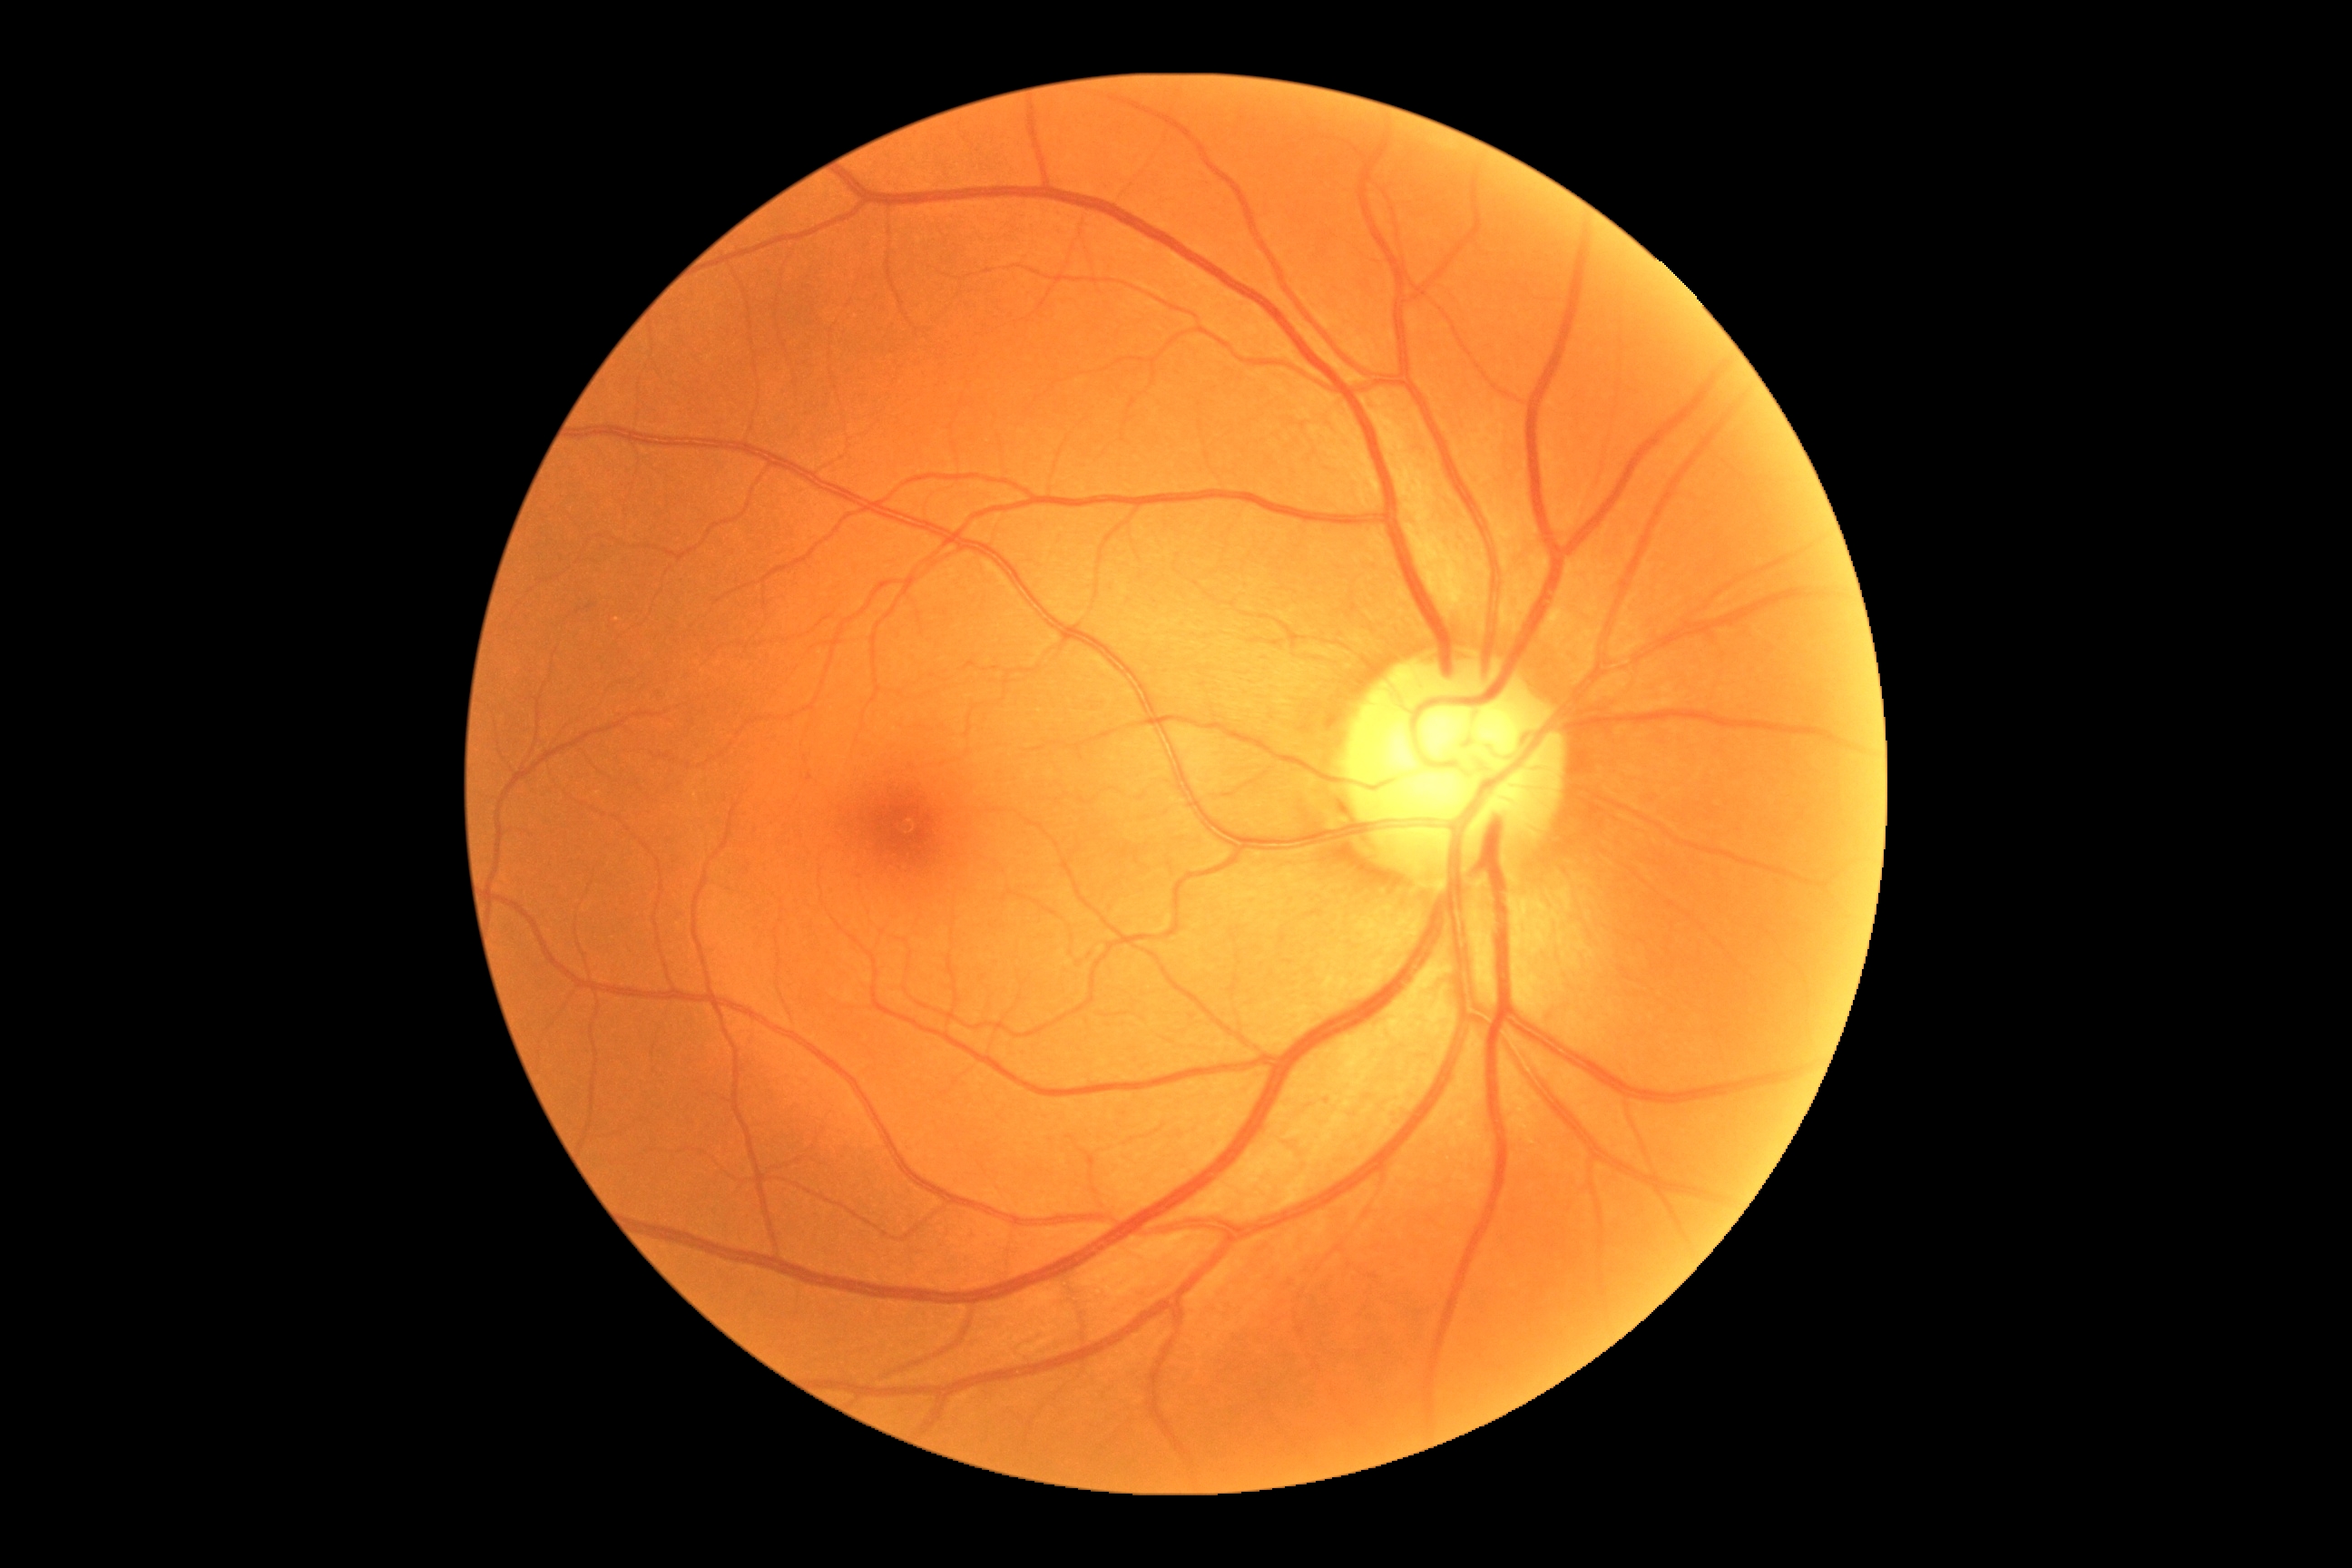

Annotations:
• DR severity — no apparent diabetic retinopathy (grade 0)